CFP
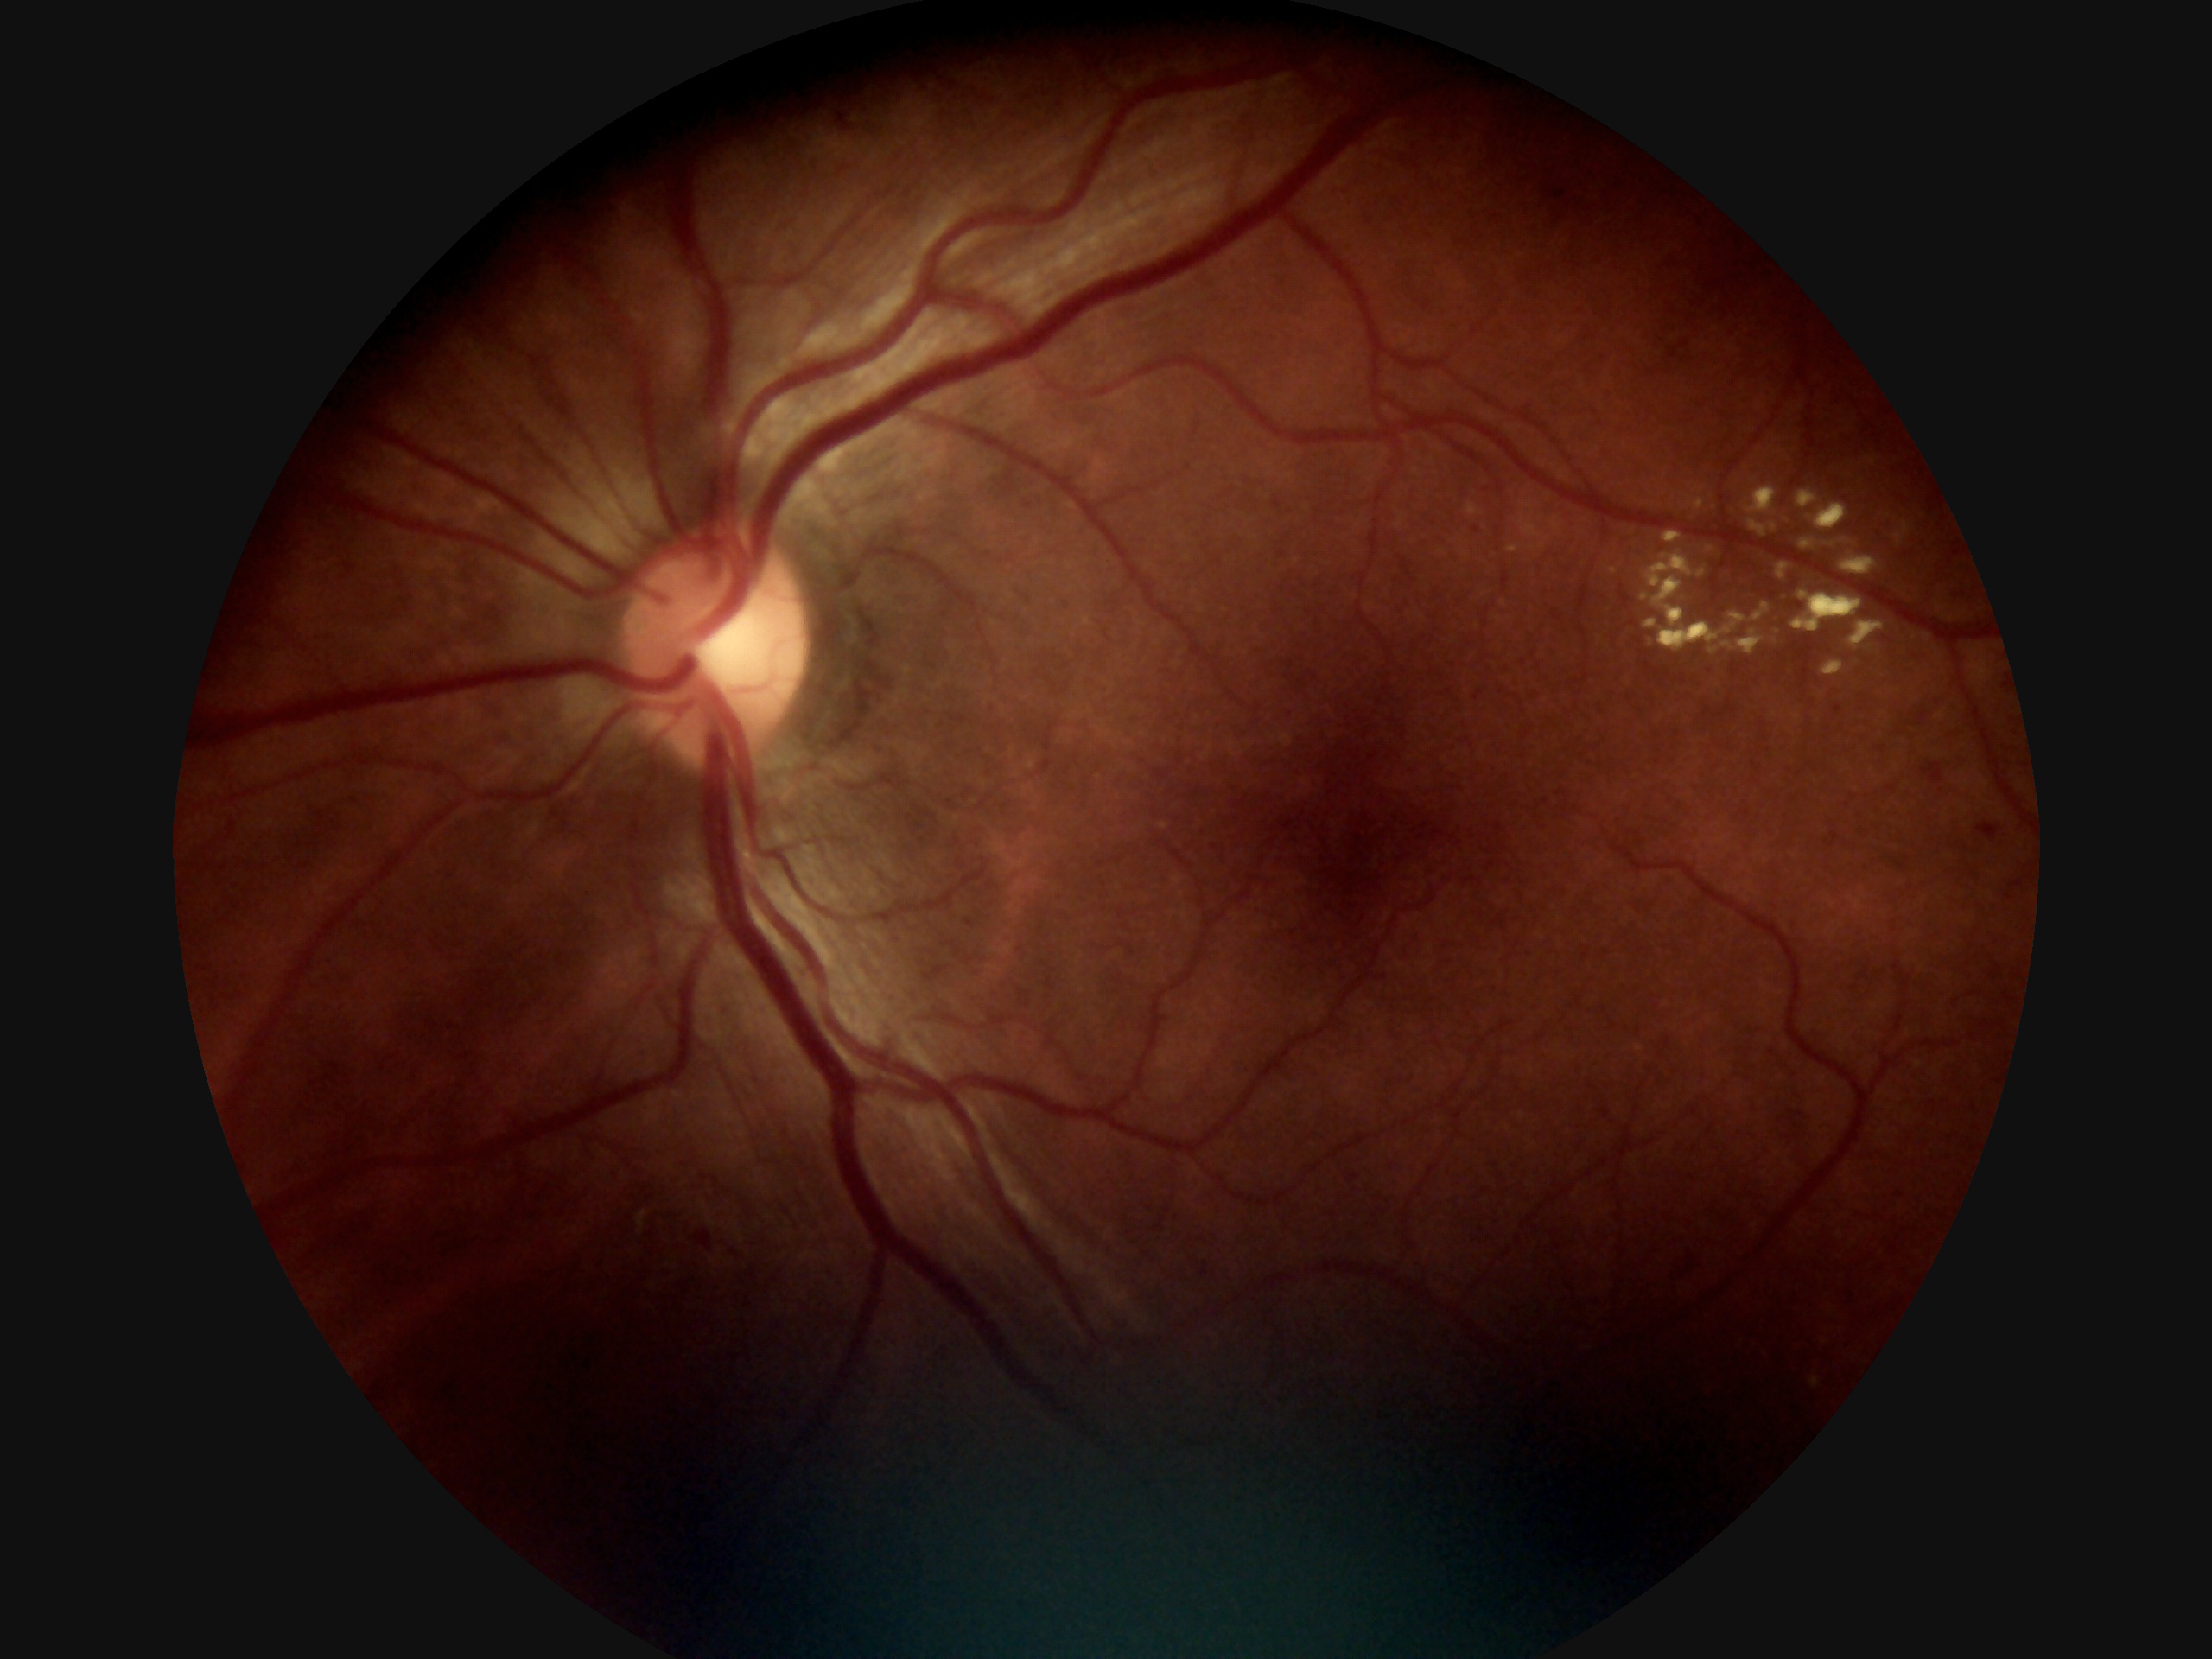

DR class = non-proliferative diabetic retinopathy | diabetic retinopathy severity = grade 2 (moderate NPDR).